848x848; CFP; without pupil dilation: 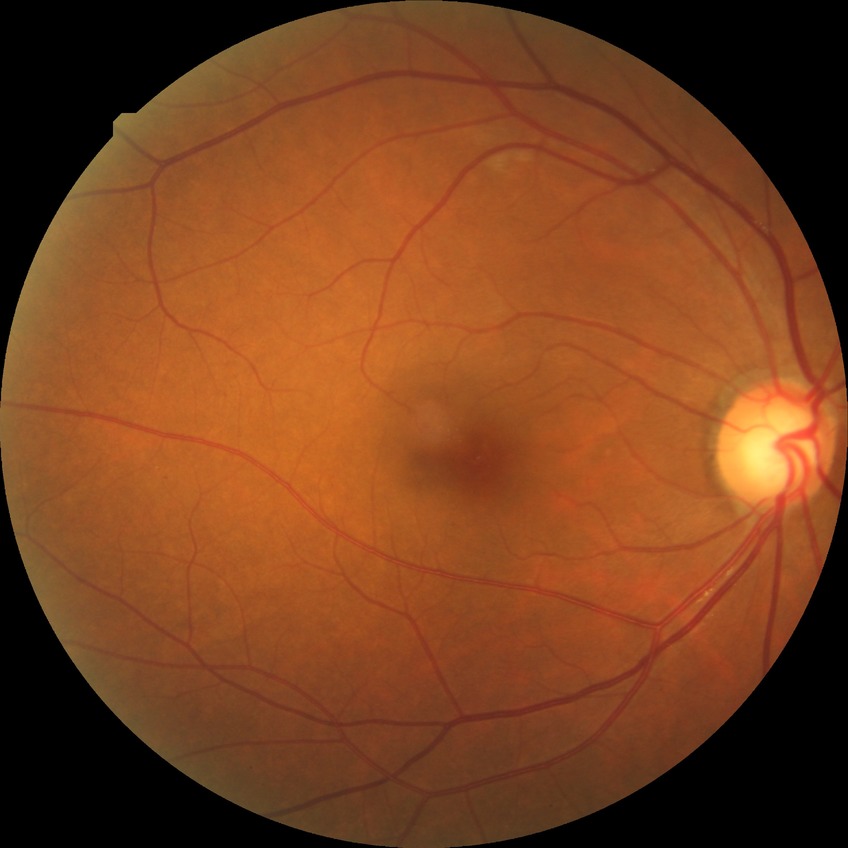

diabetic retinopathy (DR): SDR (simple diabetic retinopathy).